Color fundus image · 2346x1568px · 45-degree field of view: 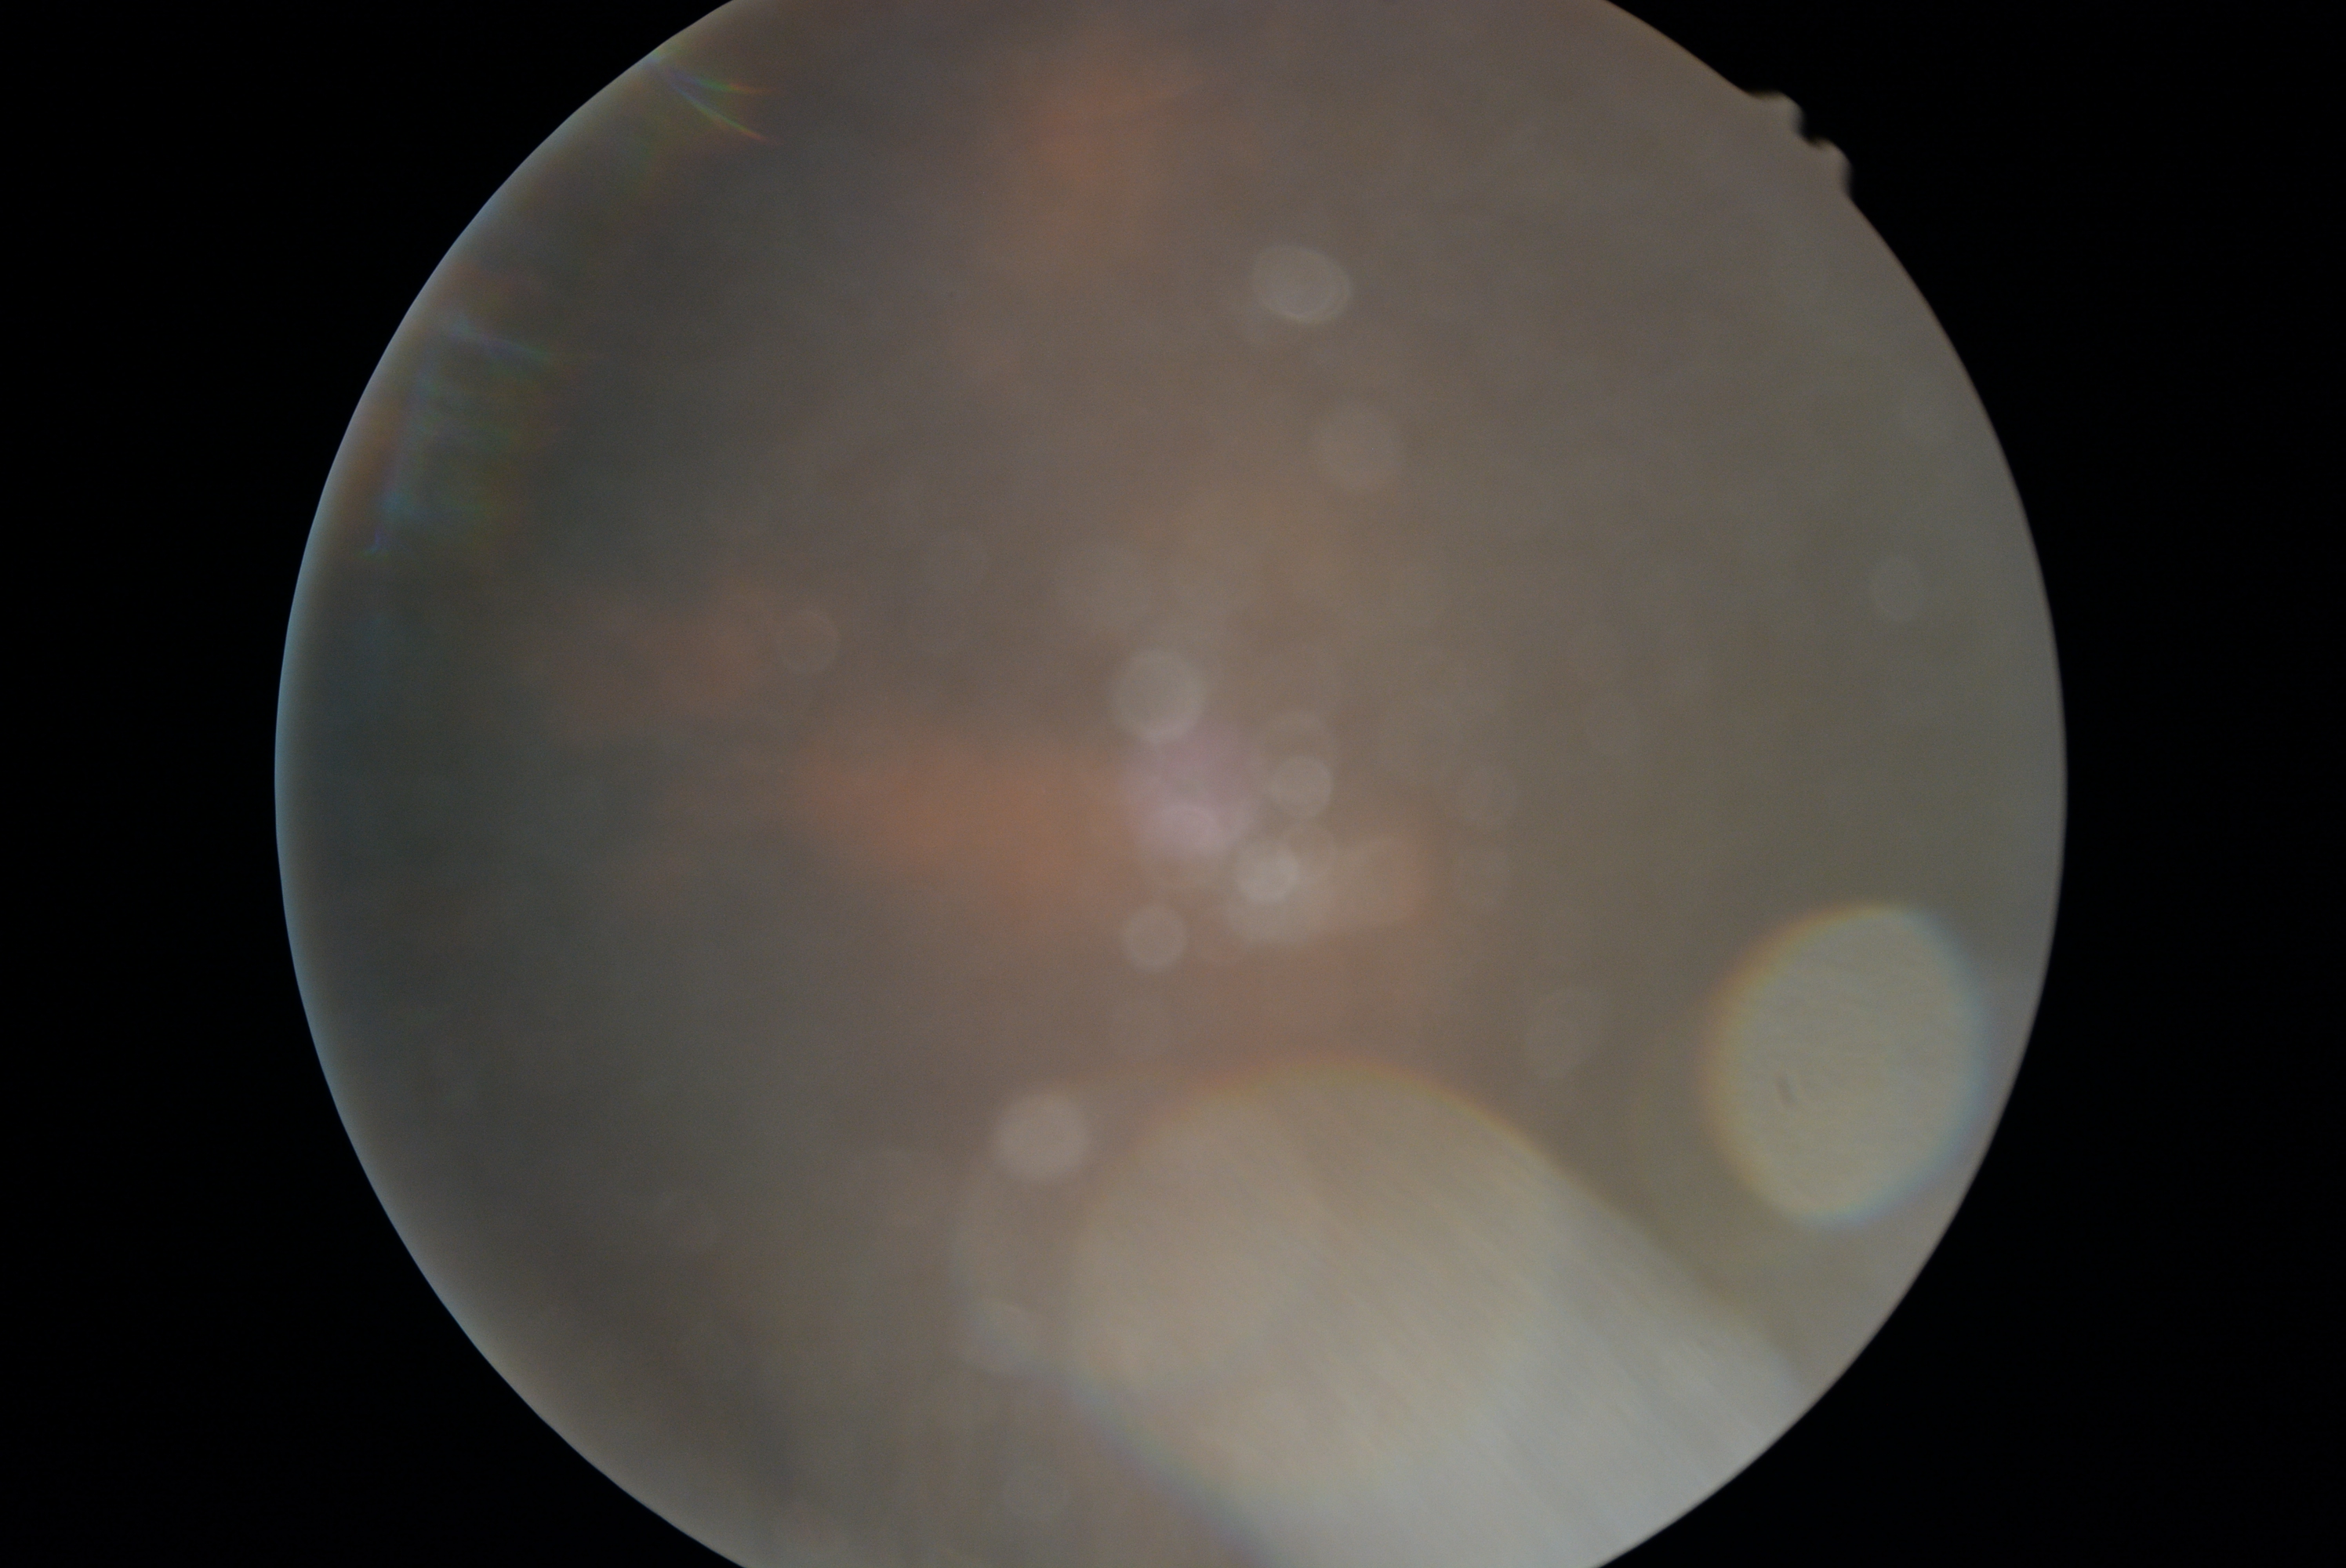
- DR severity — ungradable due to poor image quality